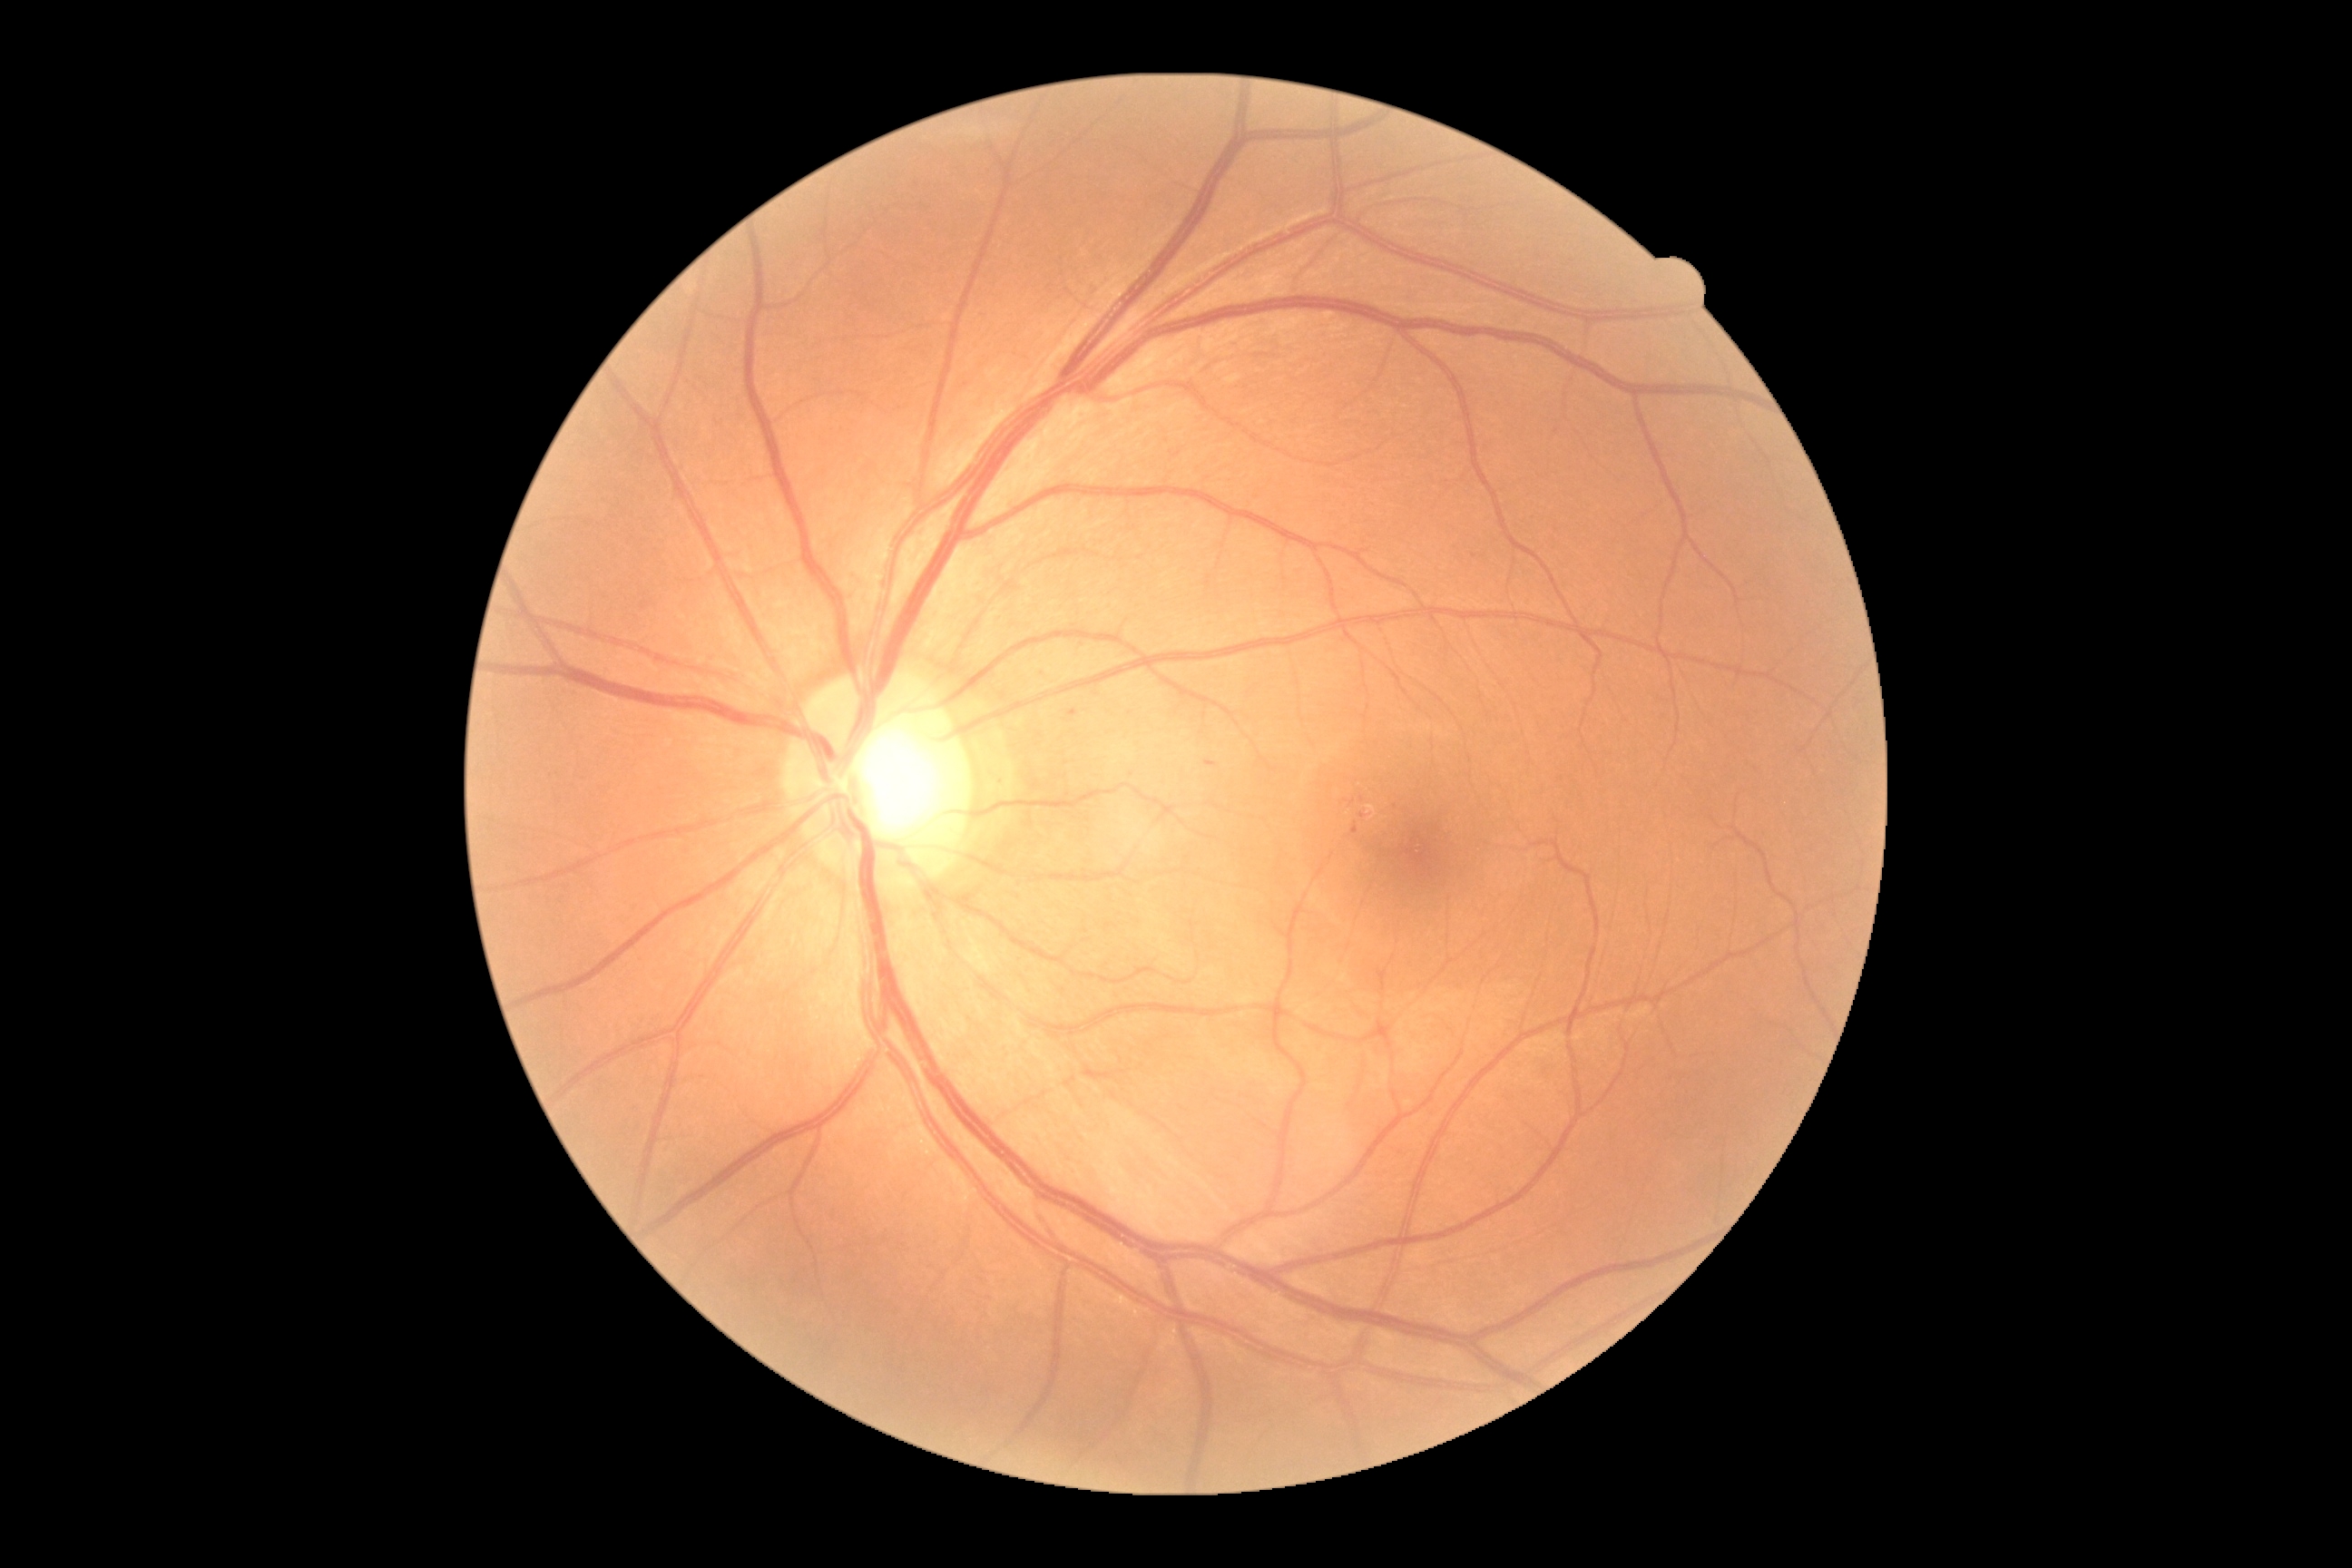
DR severity: 1